Image size 848x848; modified Davis grading:
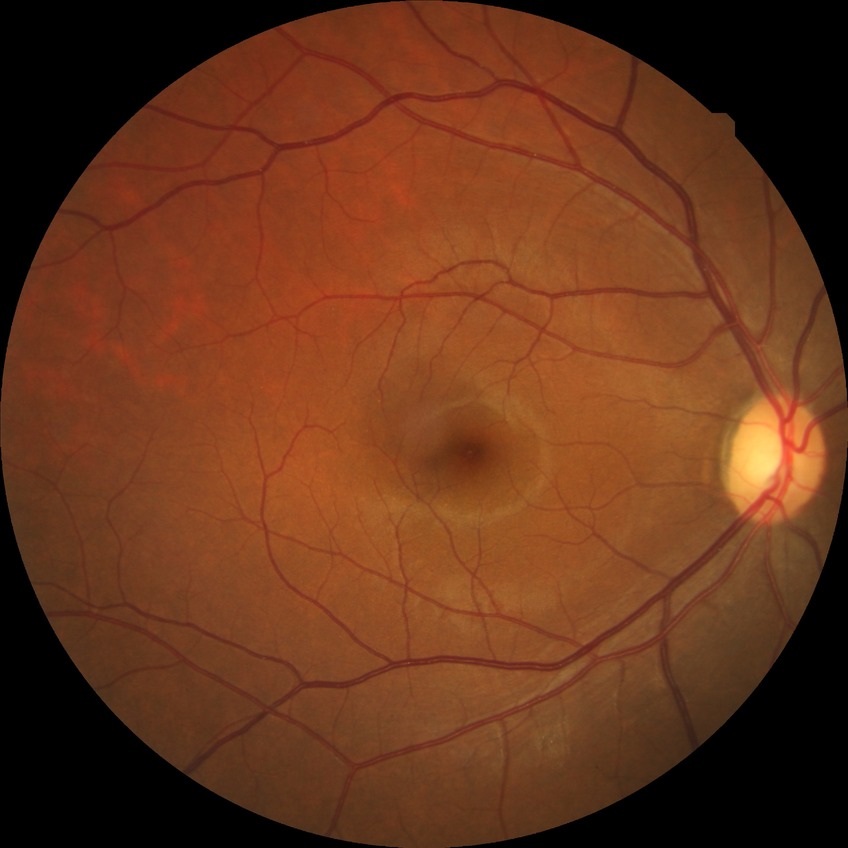

Diabetic retinopathy (DR) is no diabetic retinopathy (NDR).